1534 by 1534 pixels.
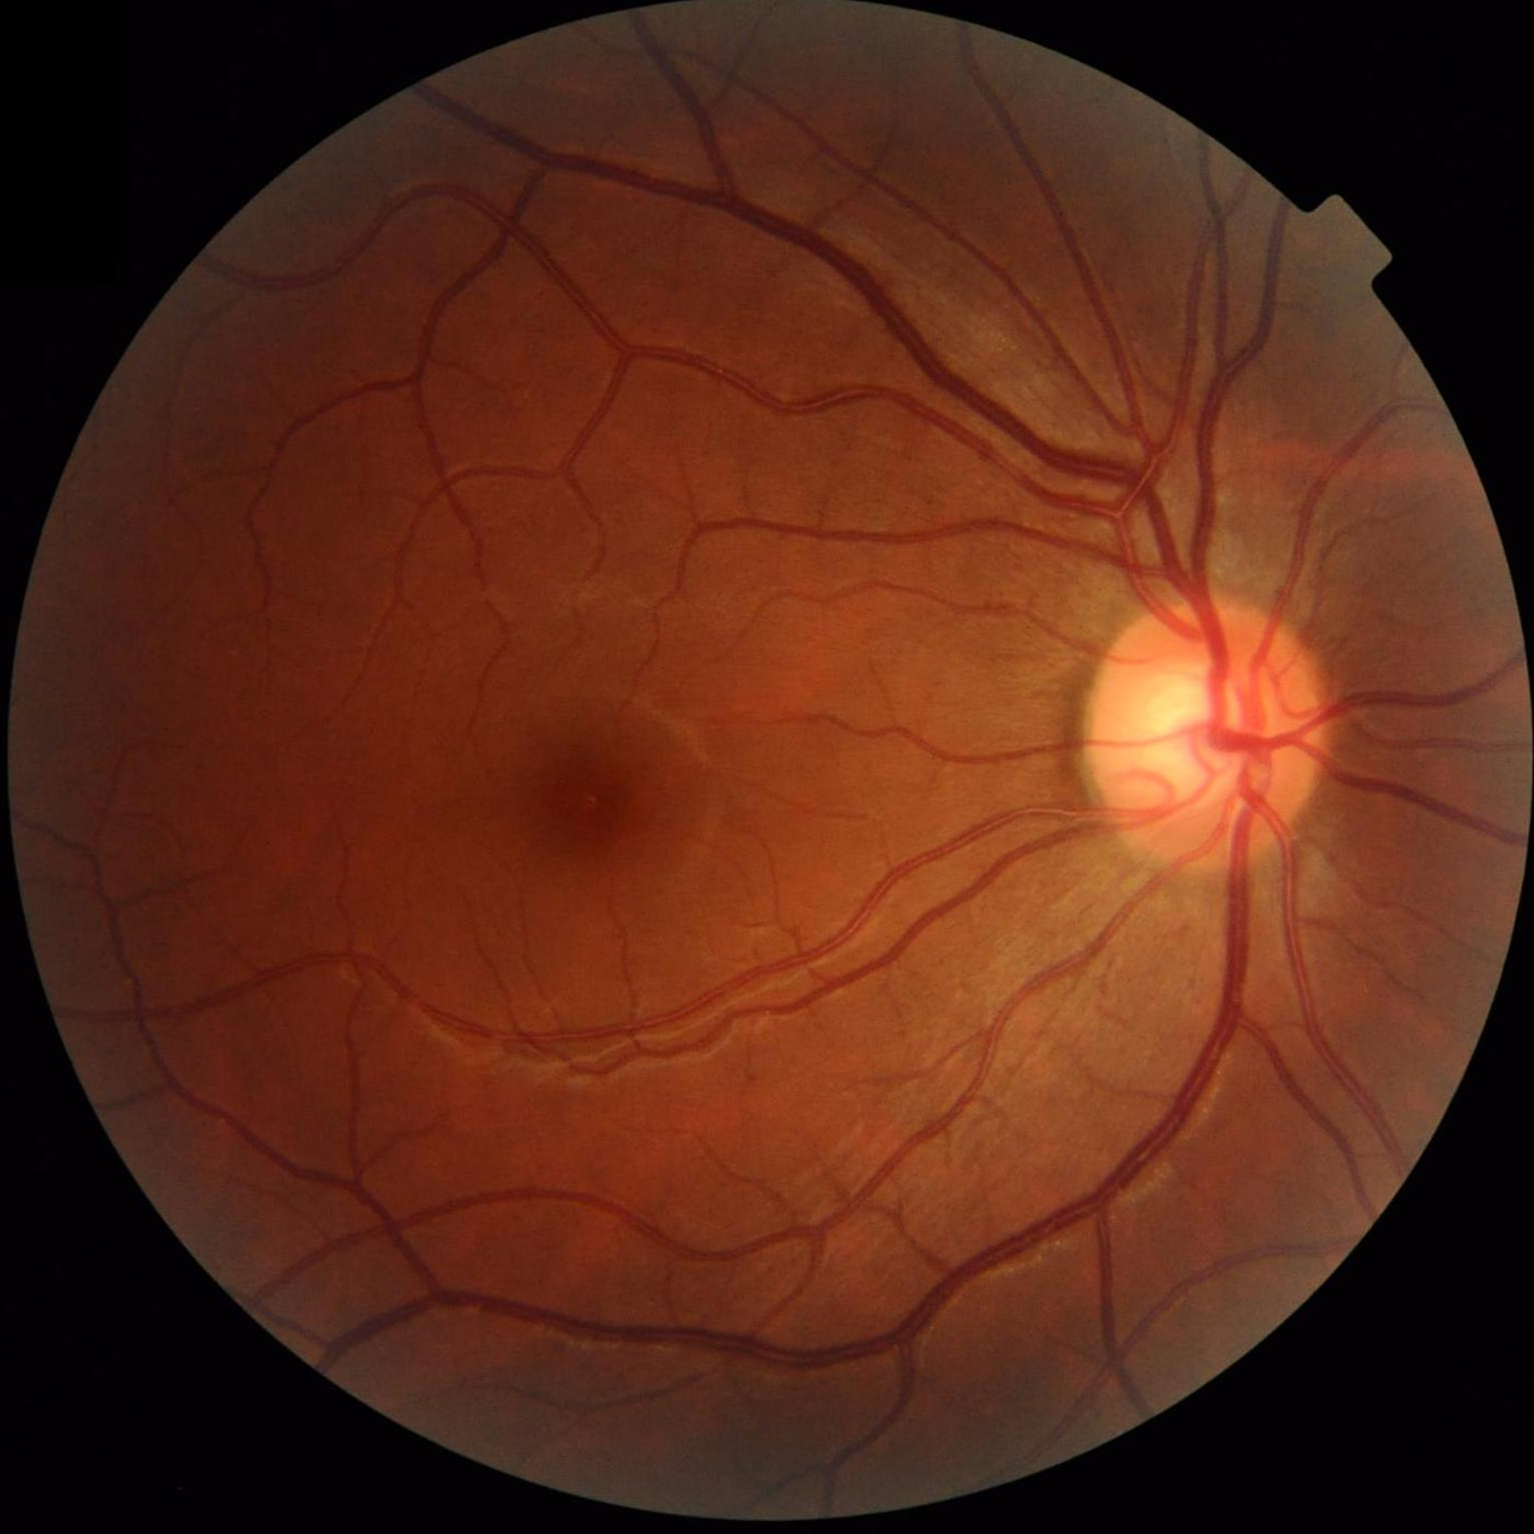 Overall image quality is good. The image is clear. Illumination and color balance are good. Good dynamic range.